CFP
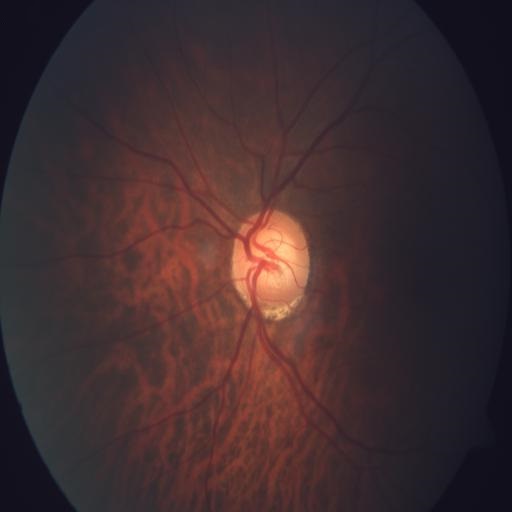

Demonstrates tessellation (TSLN).